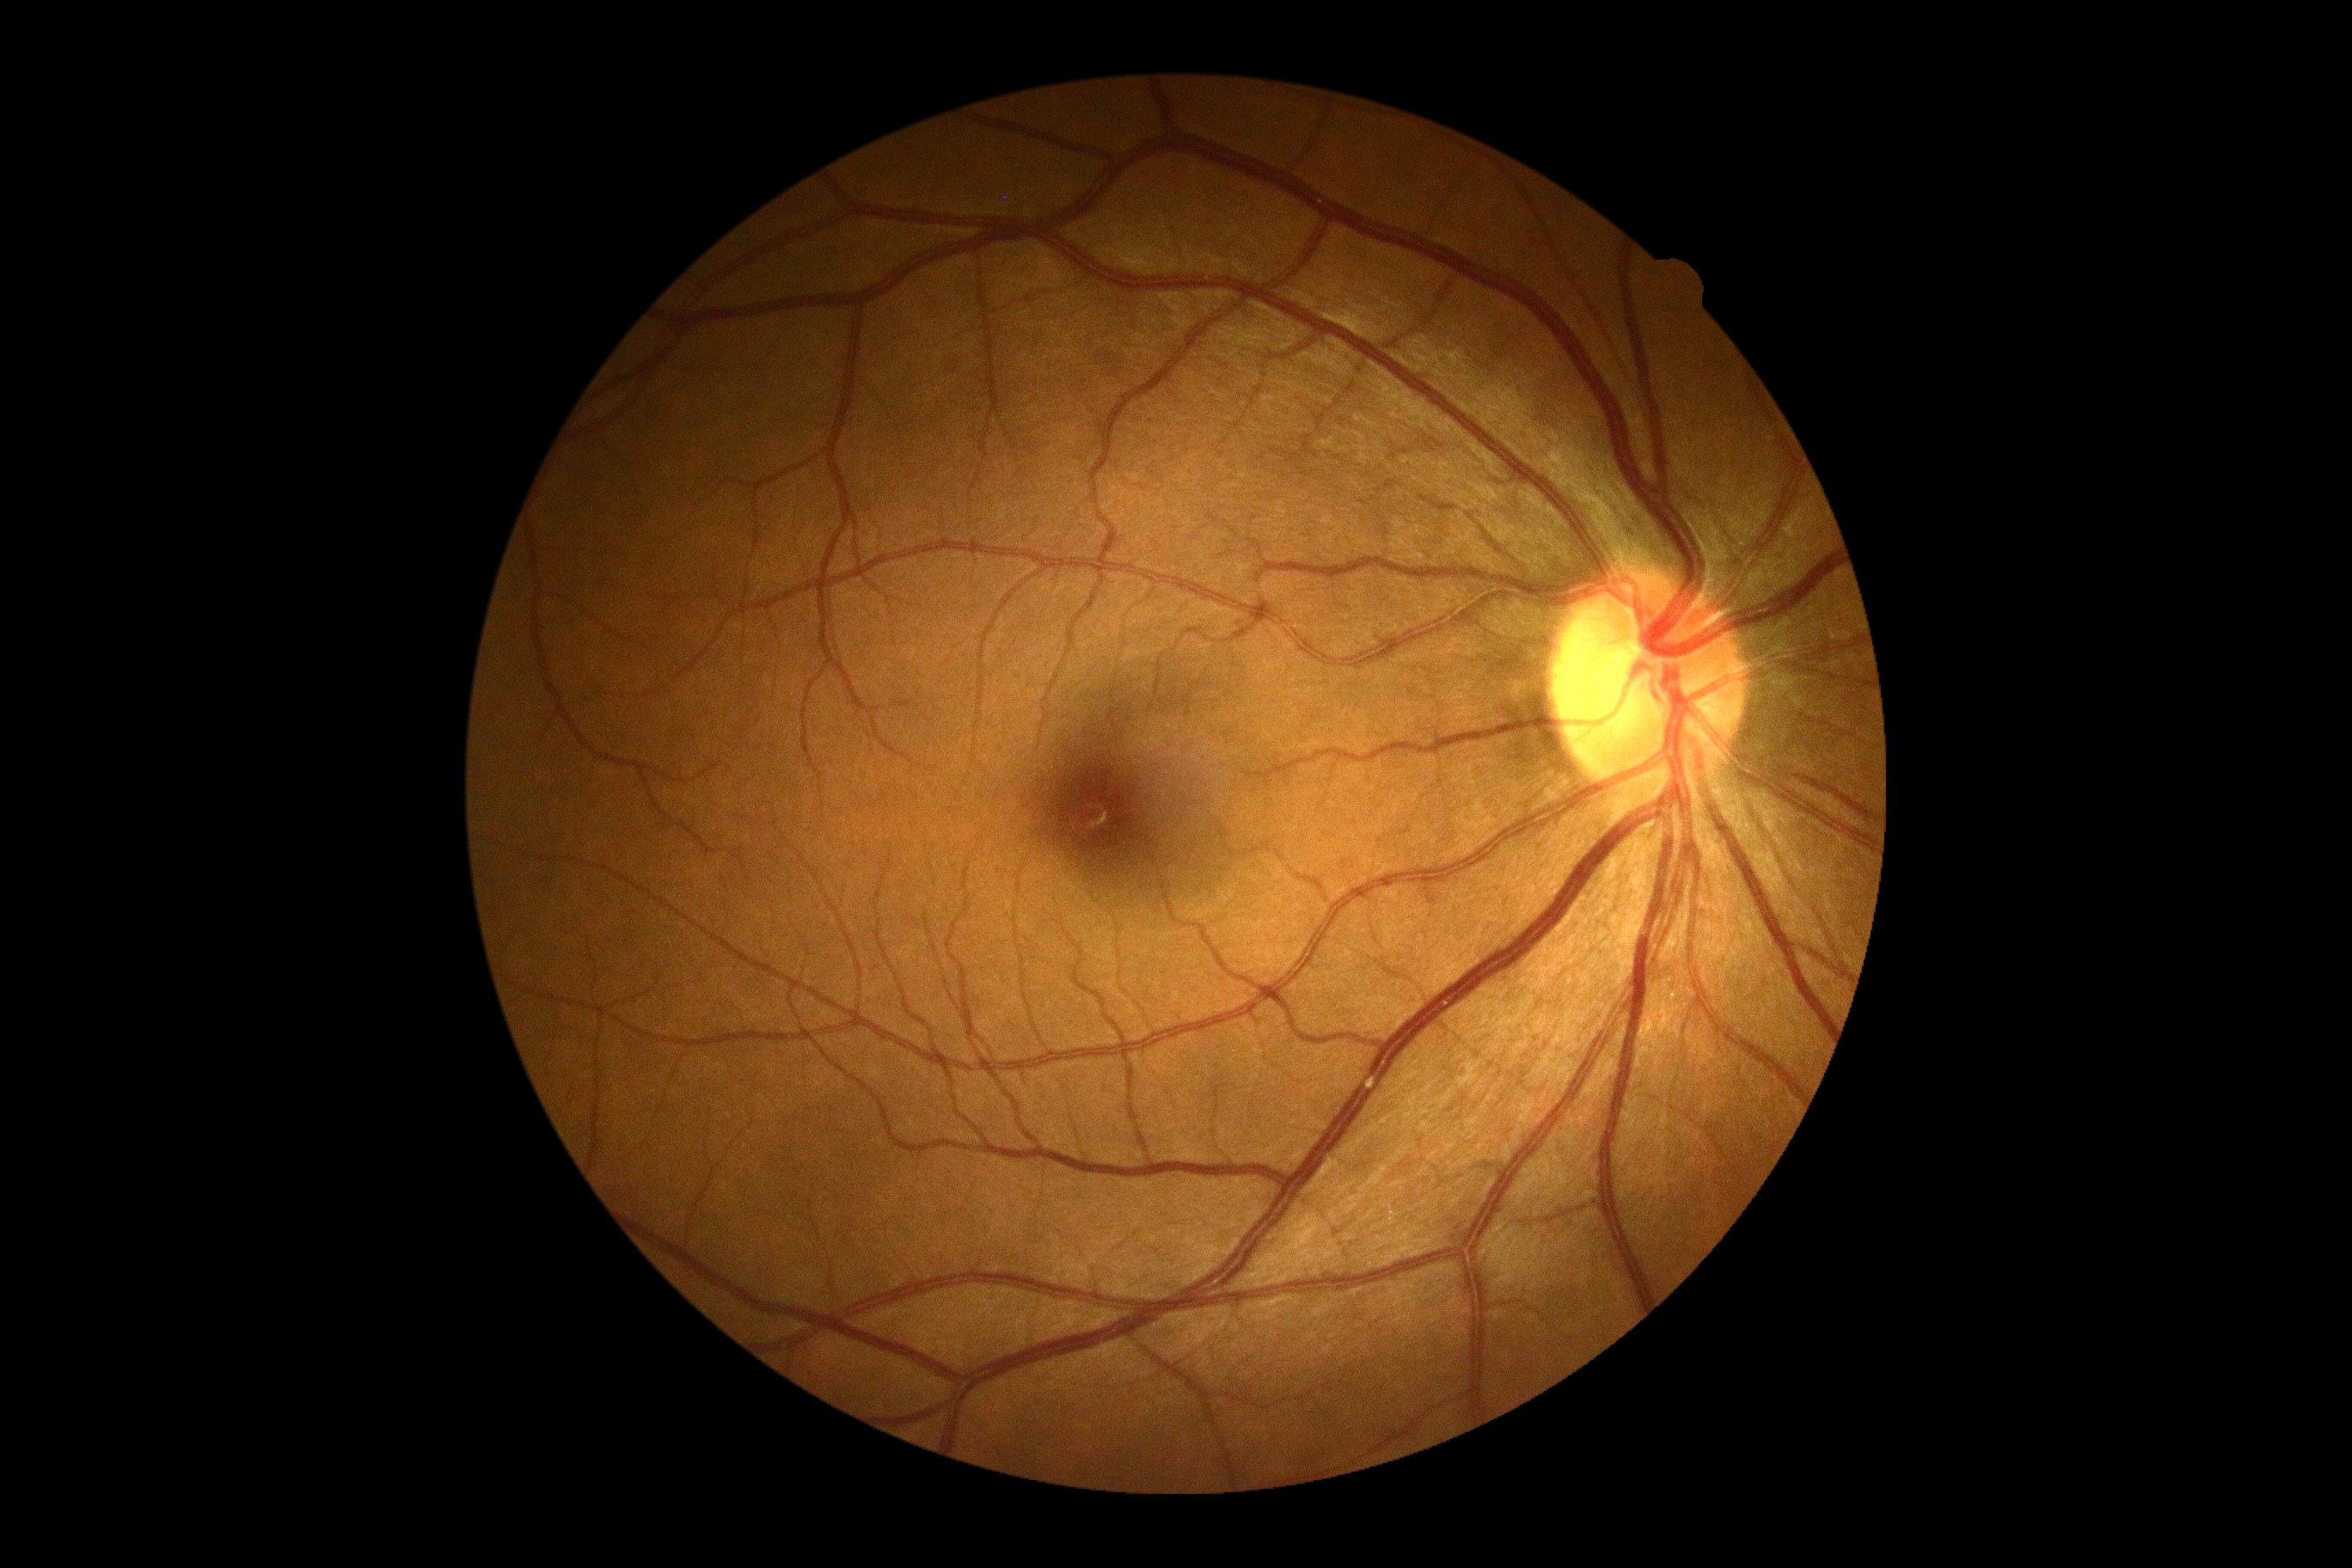
diabetic retinopathy (DR): 0.